Color fundus photograph
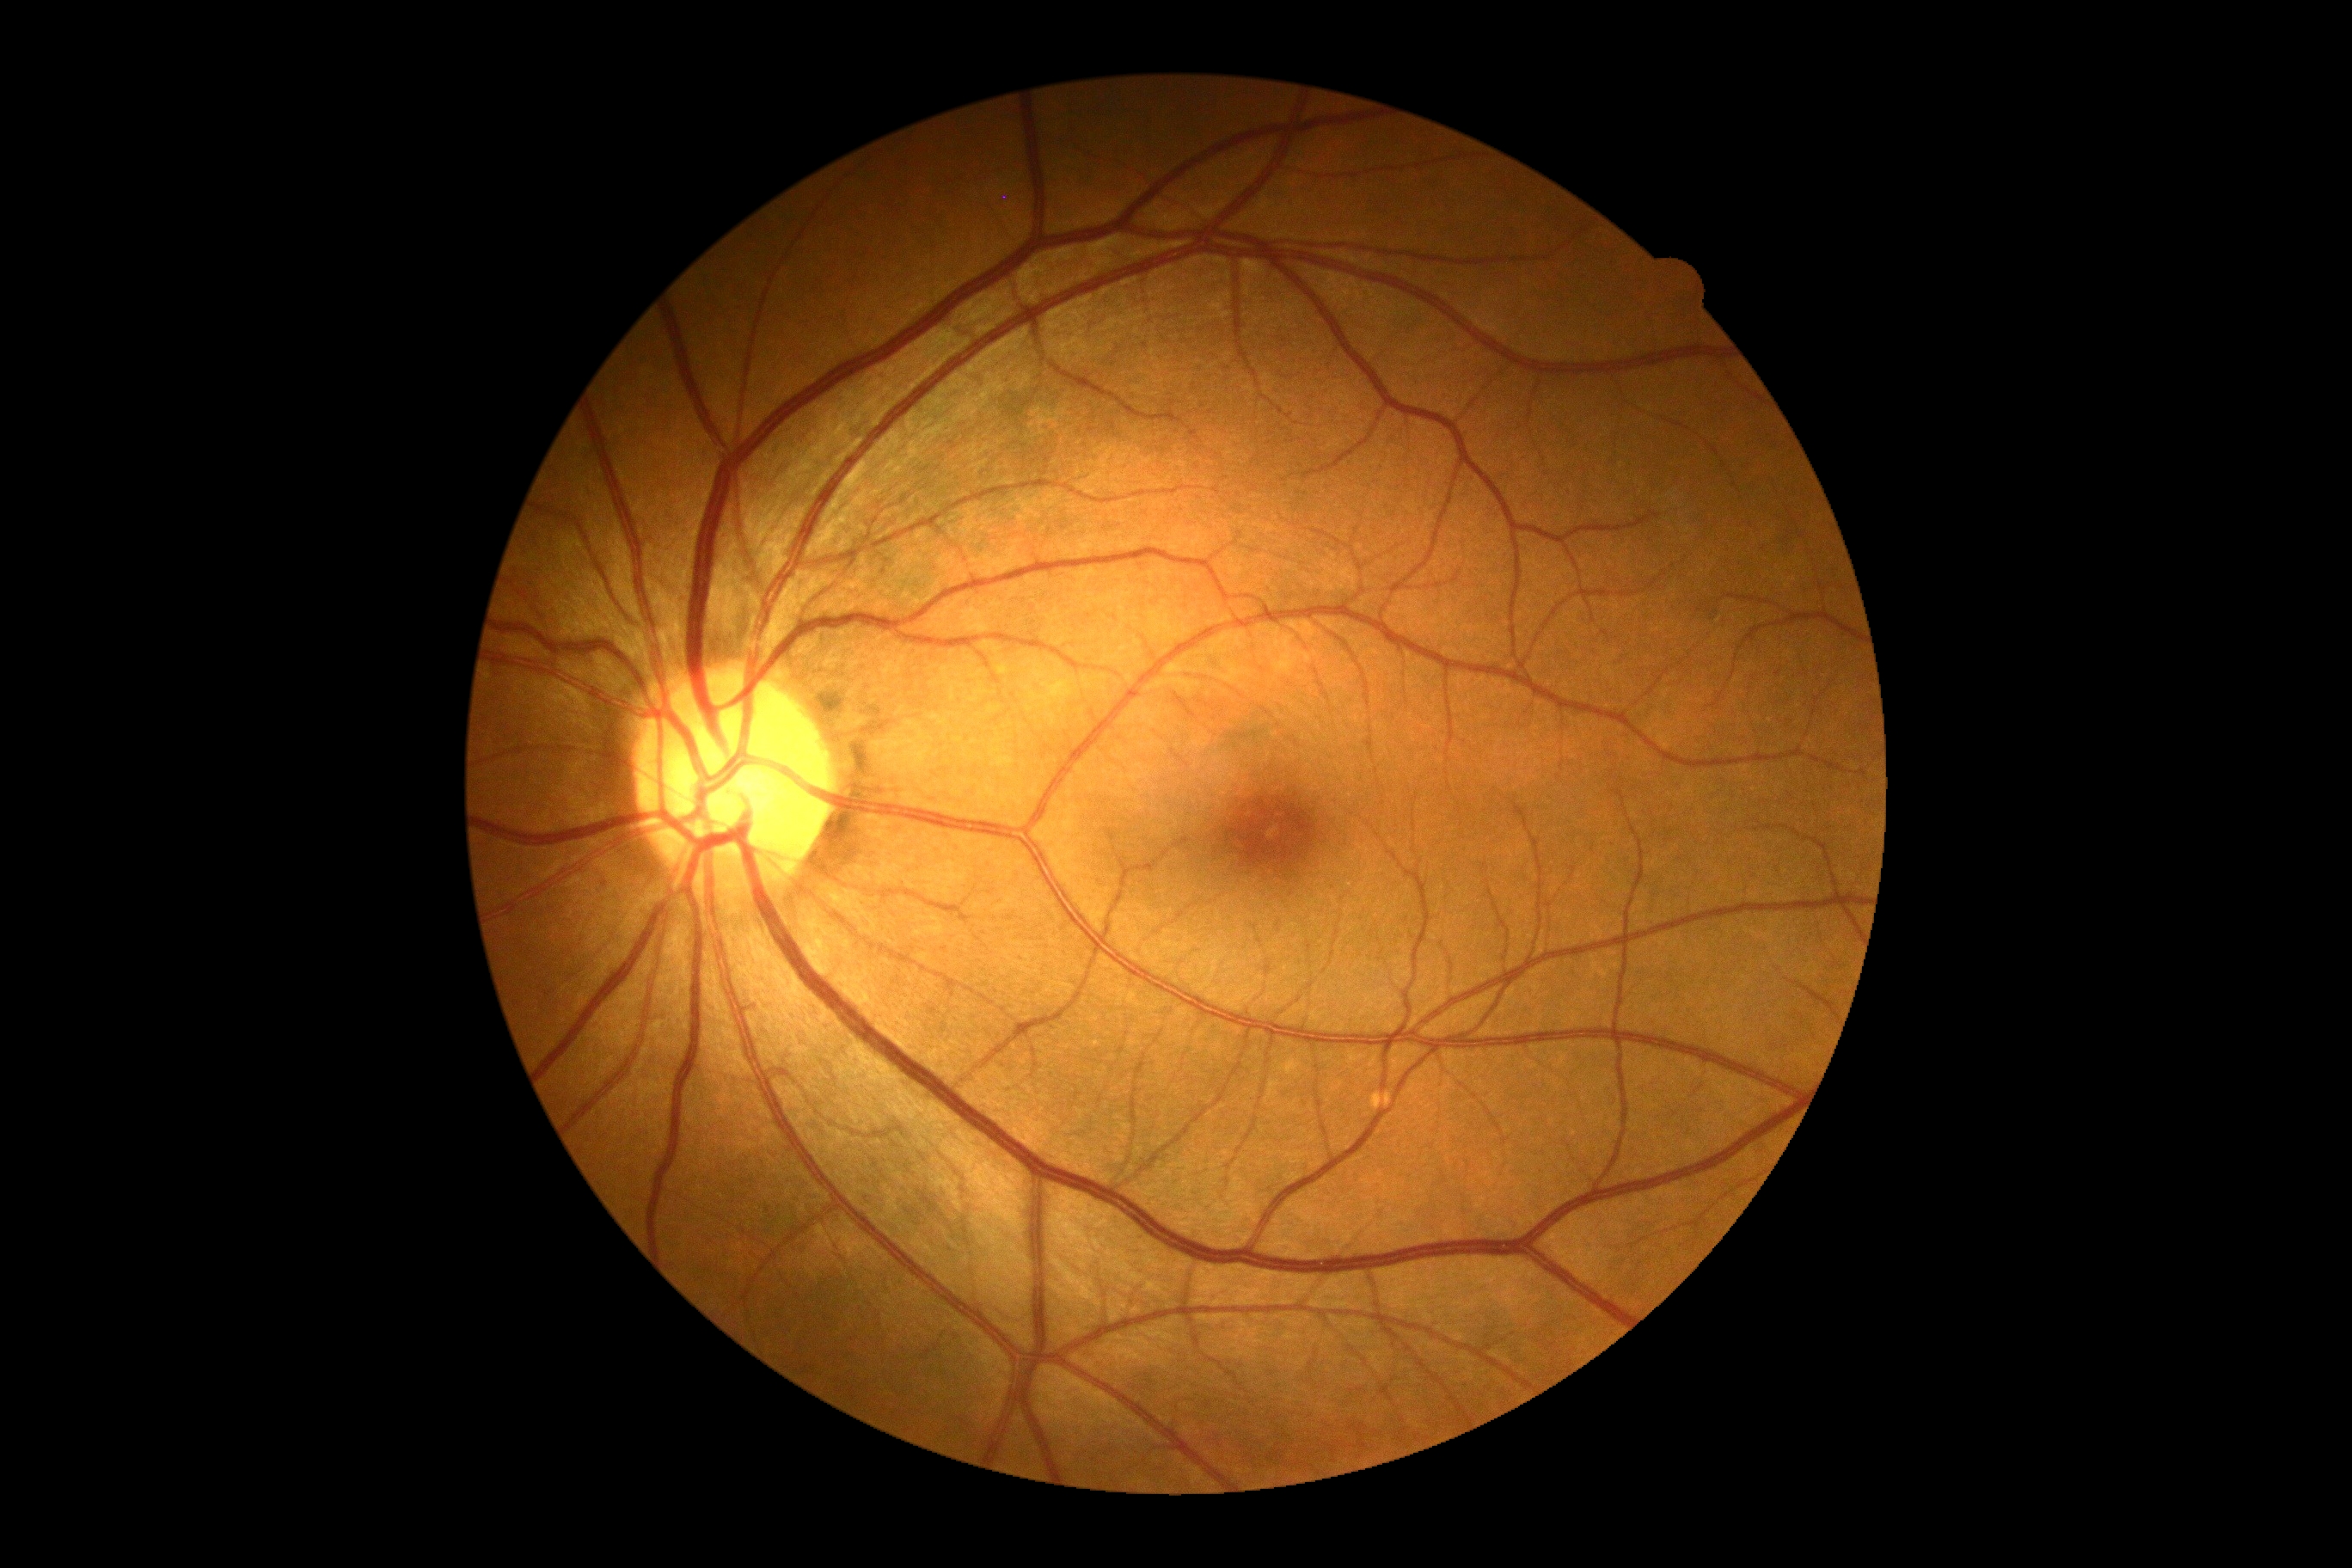 DR: grade 0 (no apparent retinopathy) | DR impression: no DR findings.